Modified Davis grading, fundus photo: 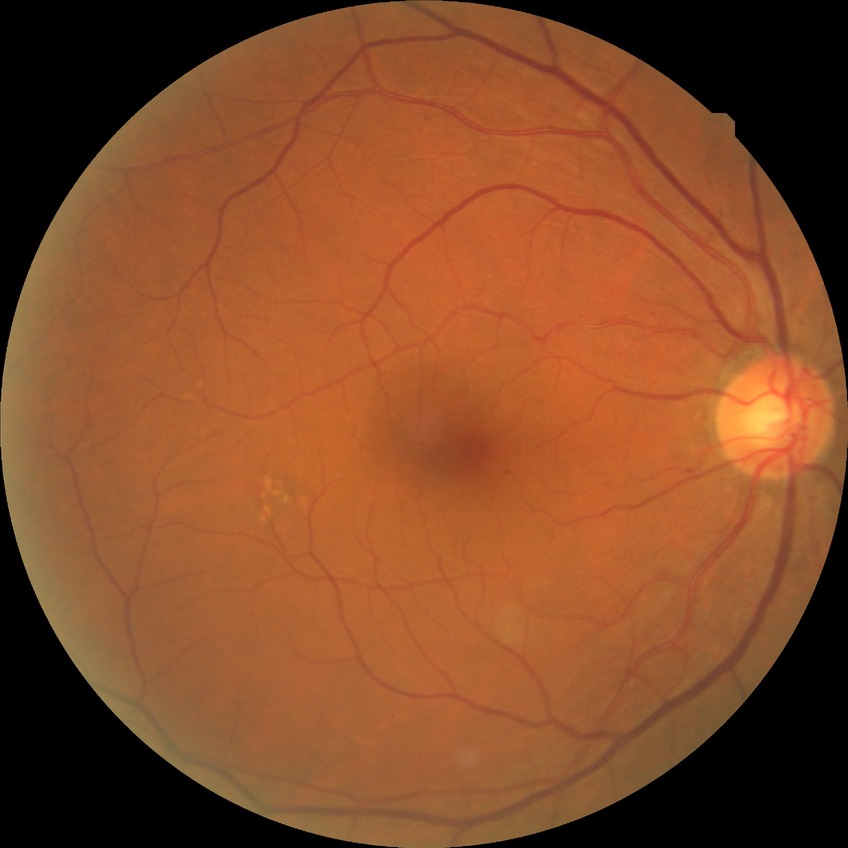 DR: SDR.